Phoenix ICON wide-field infant fundus image · 1240x1240:
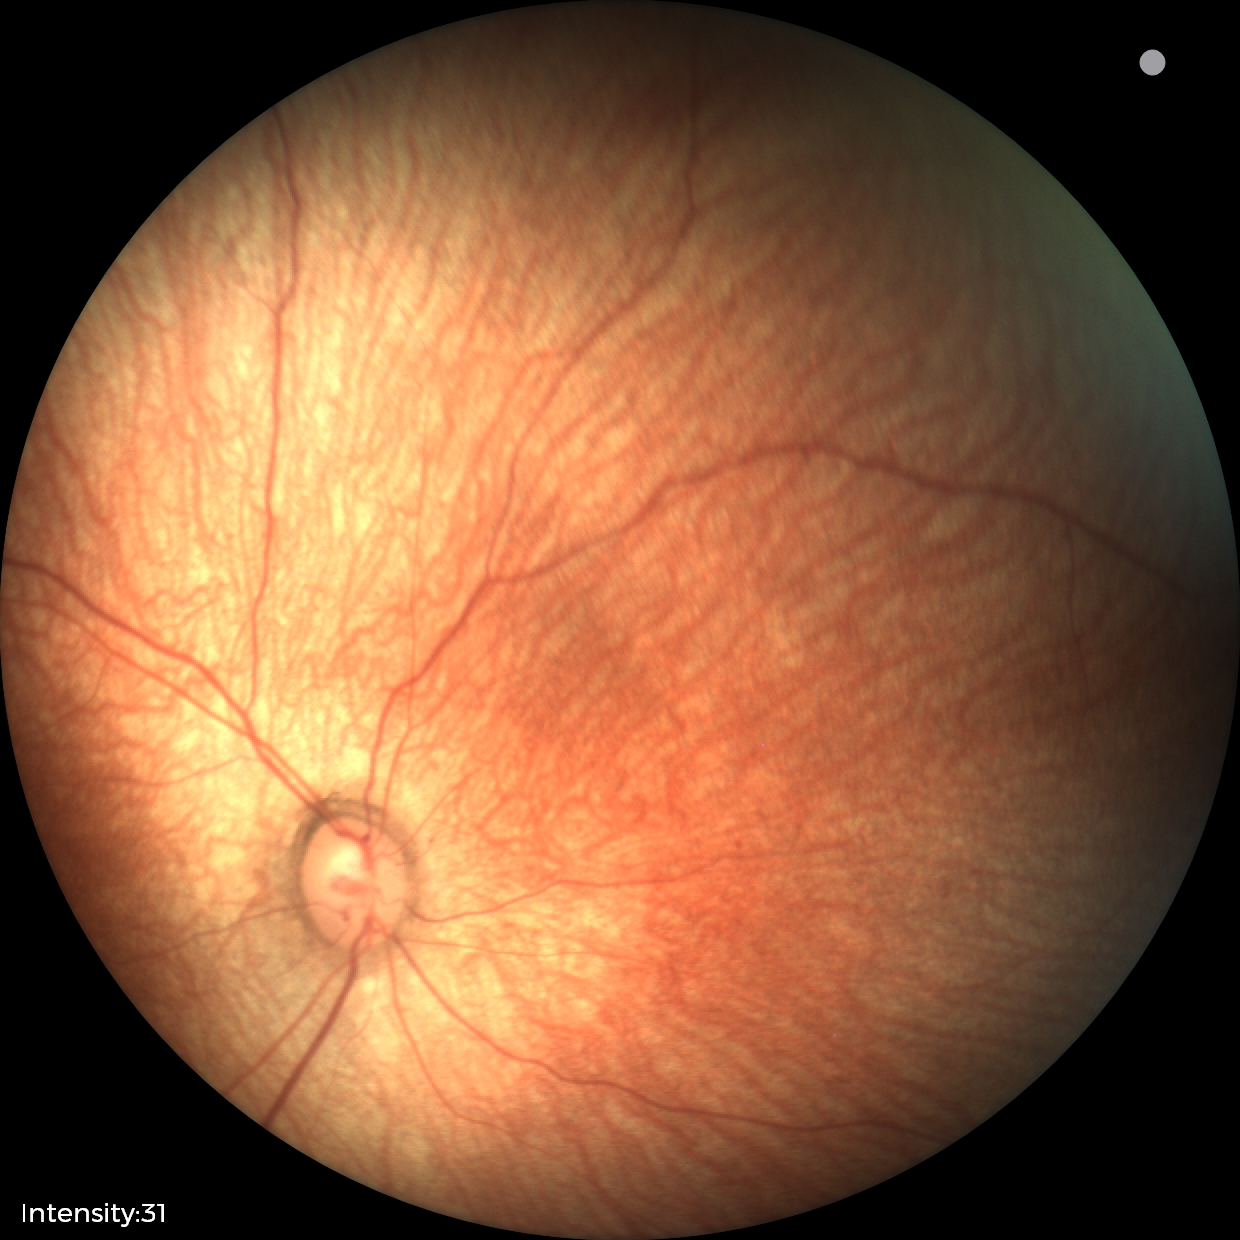 Screening diagnosis: no pathology identified.